Color fundus photograph
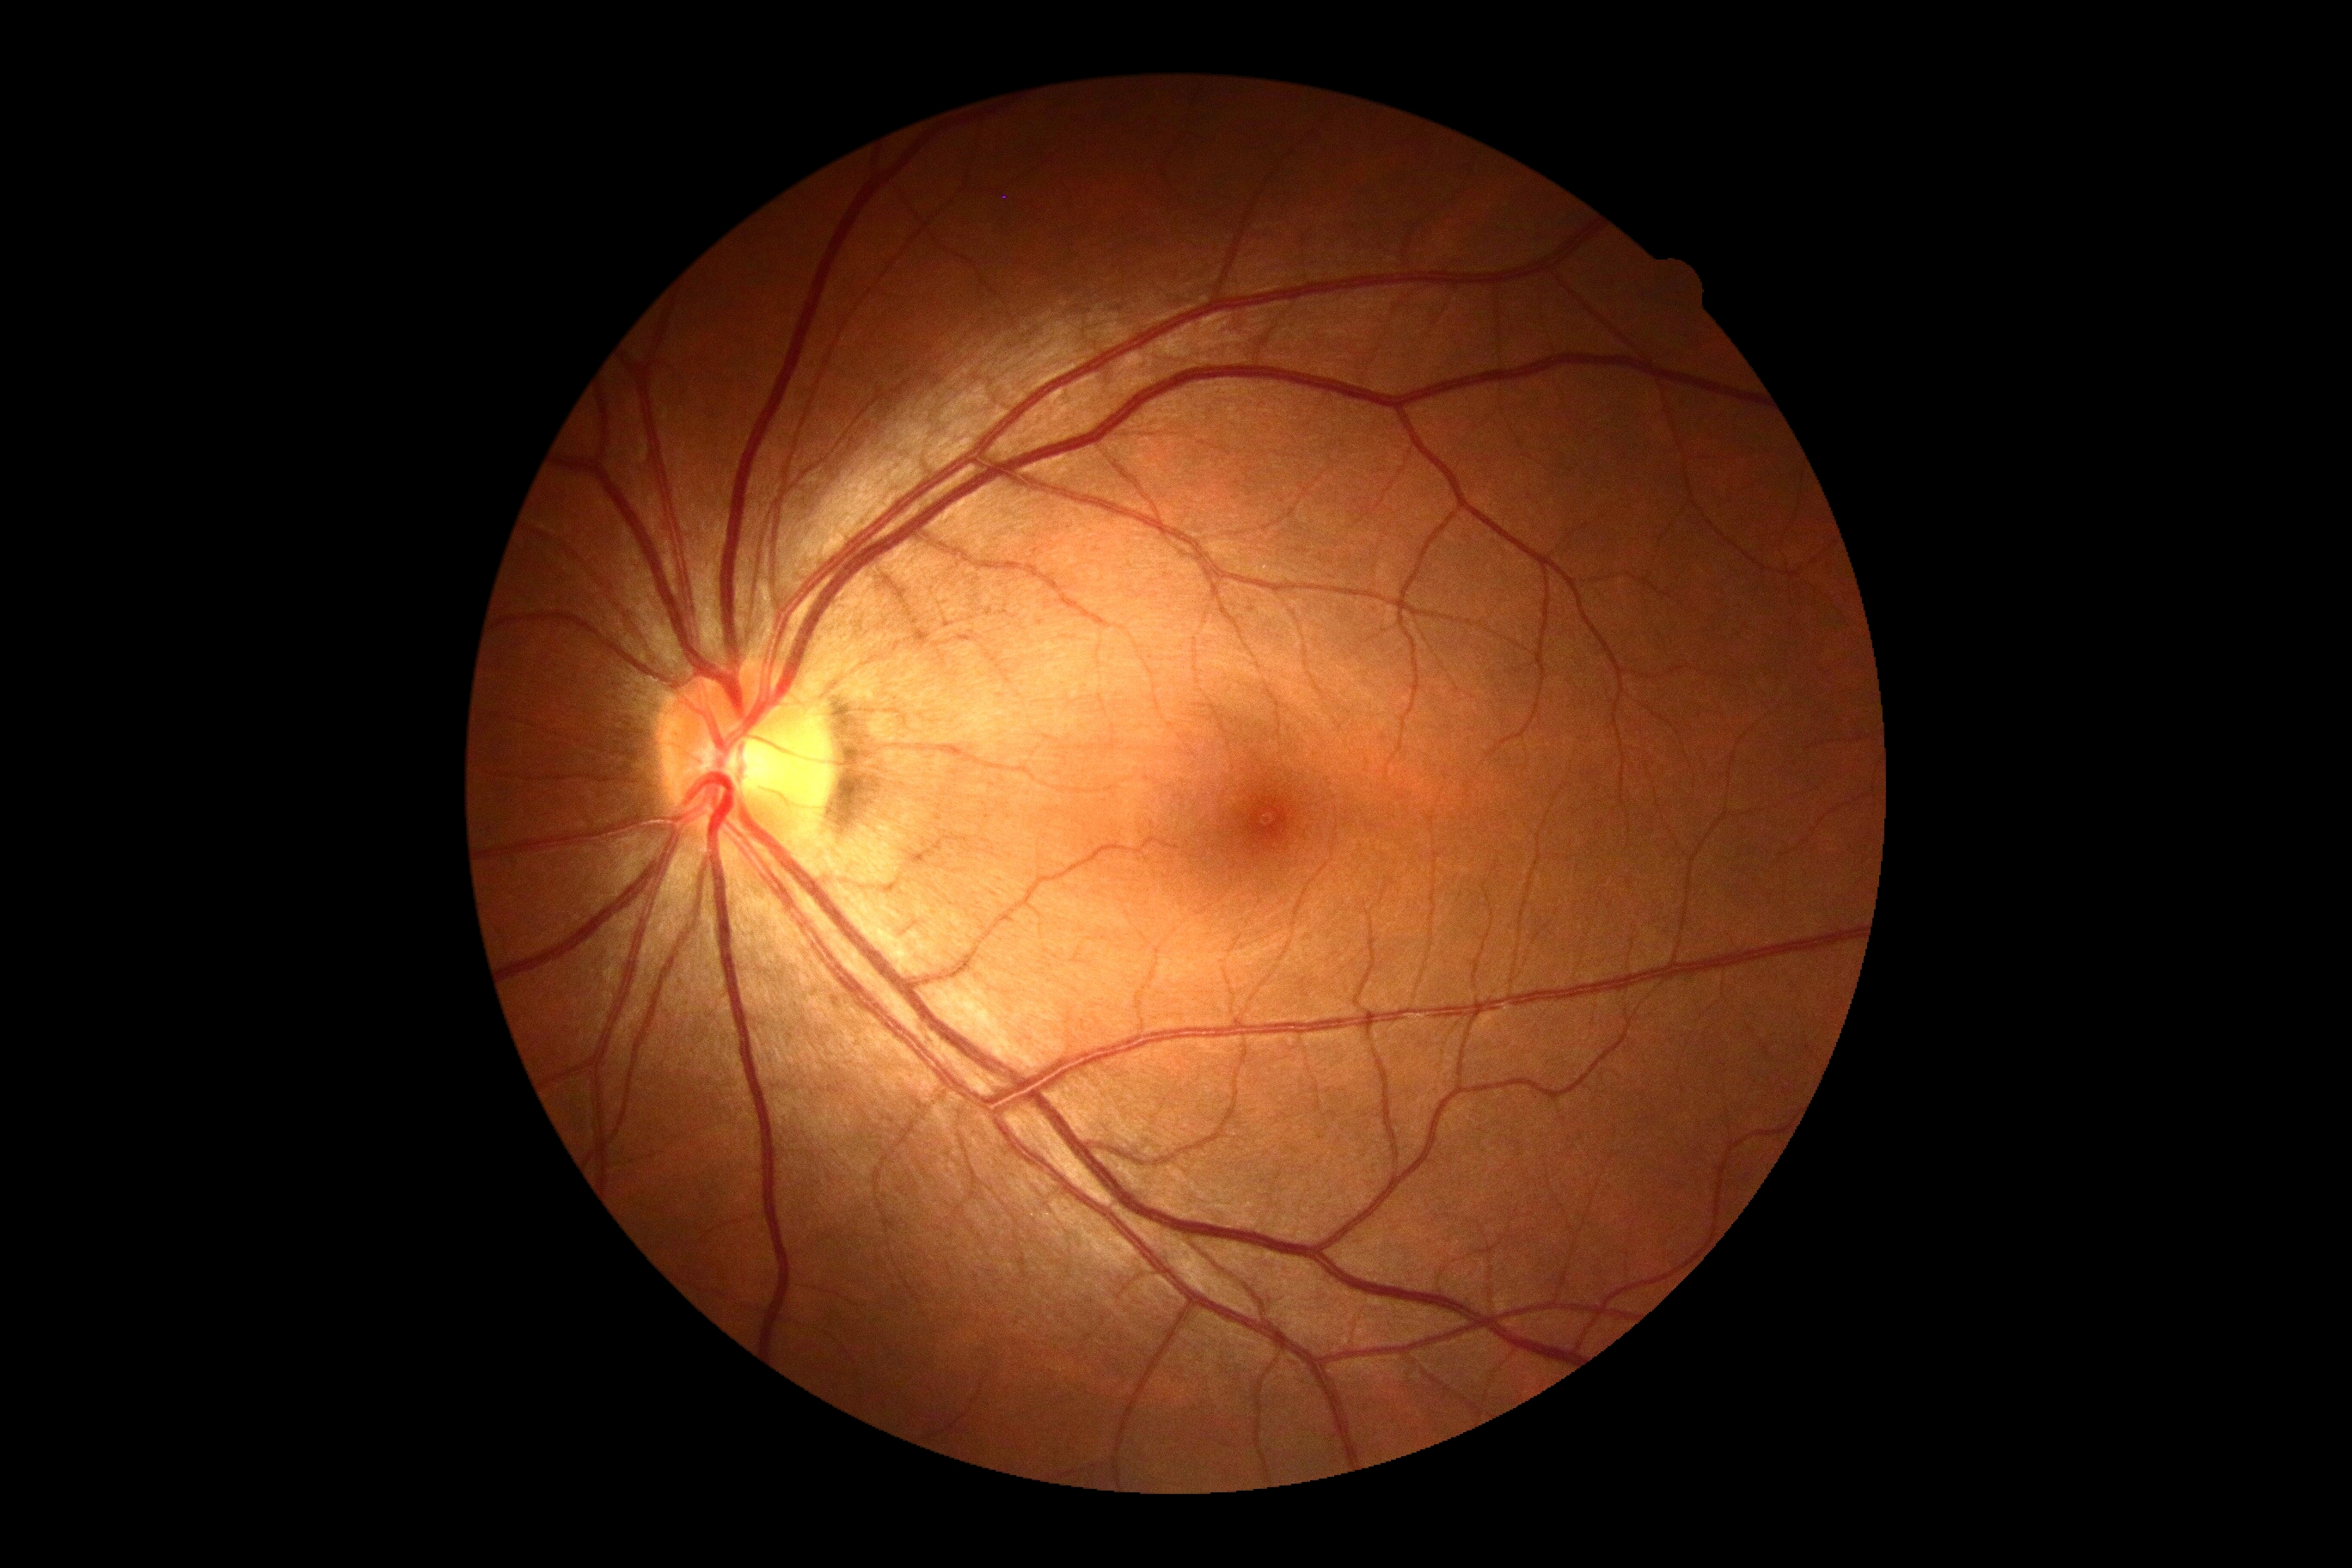

{"dr_impression": "no DR findings", "dr_grade": "no apparent diabetic retinopathy (grade 0) — no visible signs of diabetic retinopathy"}